1240x1240. Pediatric retinal photograph (wide-field):
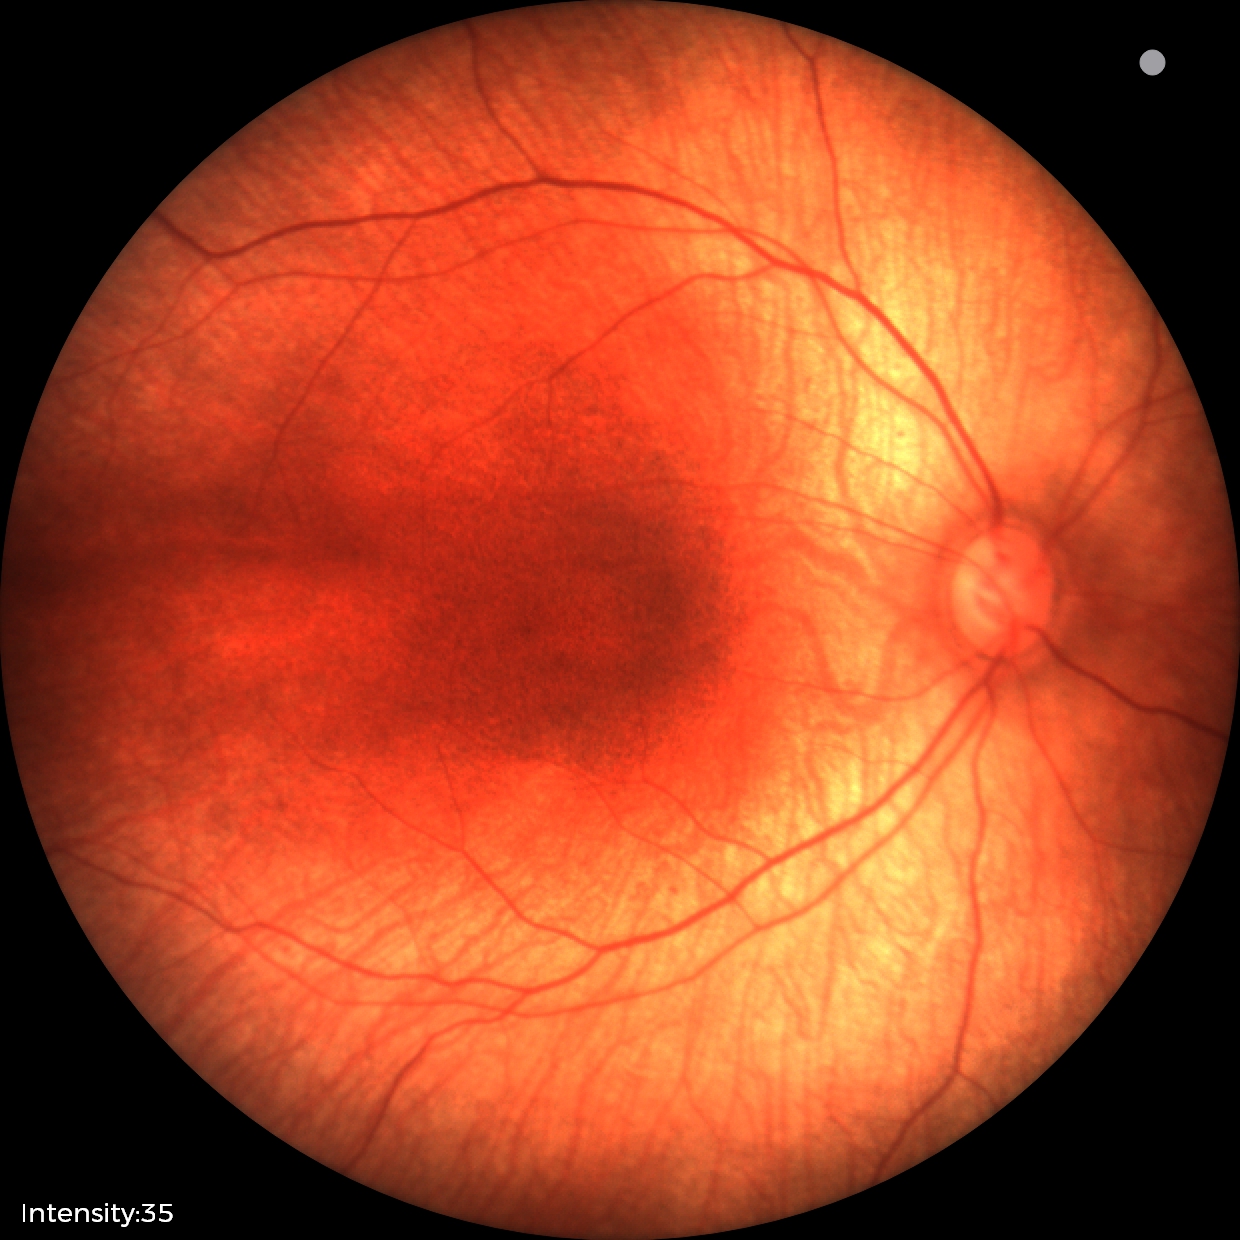

Screening examination with no abnormal retinal findings.